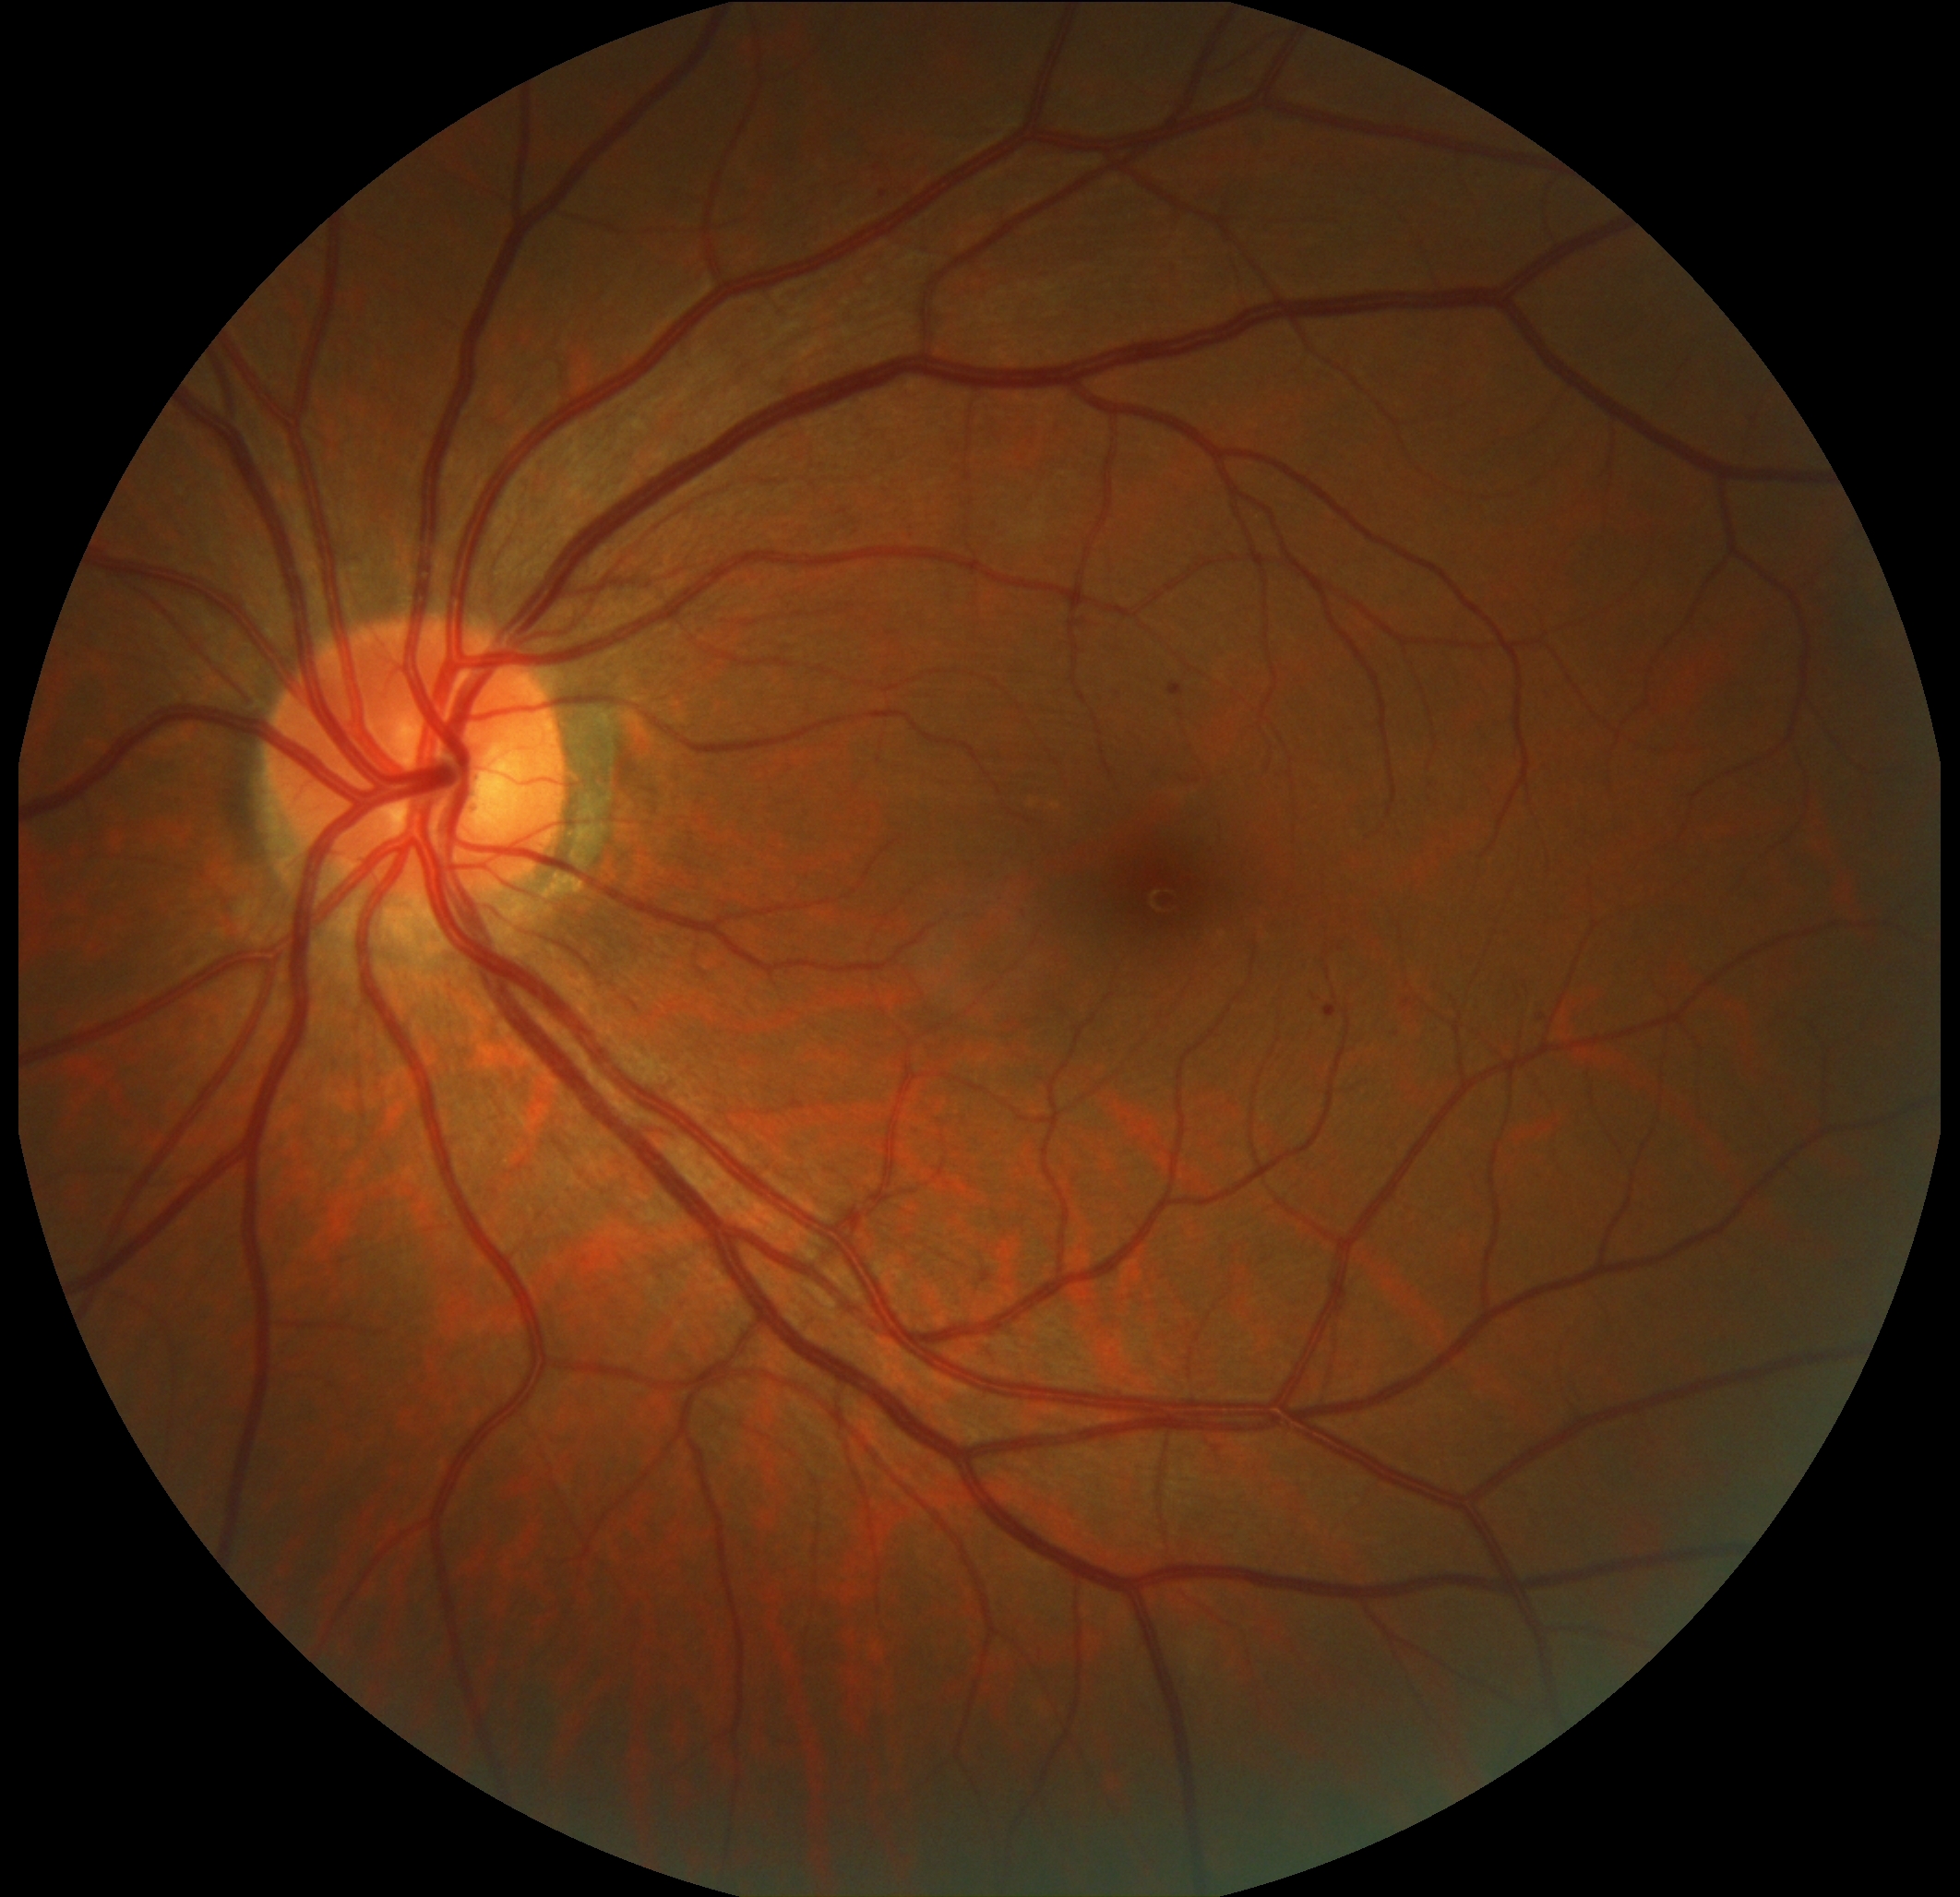 Diabetic retinopathy is 1.
No soft exudates identified.
Microaneurysms located at x1=1403, y1=998, x2=1414, y2=1010; x1=981, y1=1272, x2=992, y2=1282; x1=1429, y1=781, x2=1440, y2=796; x1=1168, y1=684, x2=1185, y2=697; x1=1324, y1=1004, x2=1337, y2=1018; x1=1533, y1=1010, x2=1544, y2=1018.
Additional small microaneurysms near [1398,1035]; [884,194].
No hard exudates identified.
No hemorrhages identified.